Nonmydriatic fundus photograph. Acquired with a NIDEK AFC-230. 848 x 848 pixels:
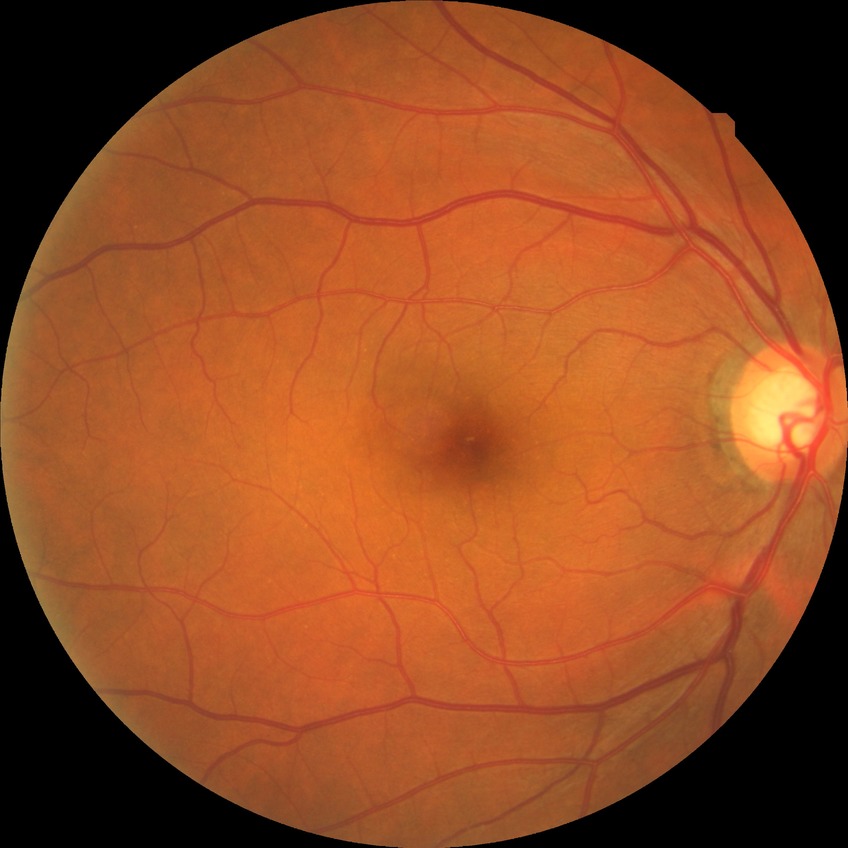

diabetic retinopathy (DR)=no diabetic retinopathy (NDR).